CFP — 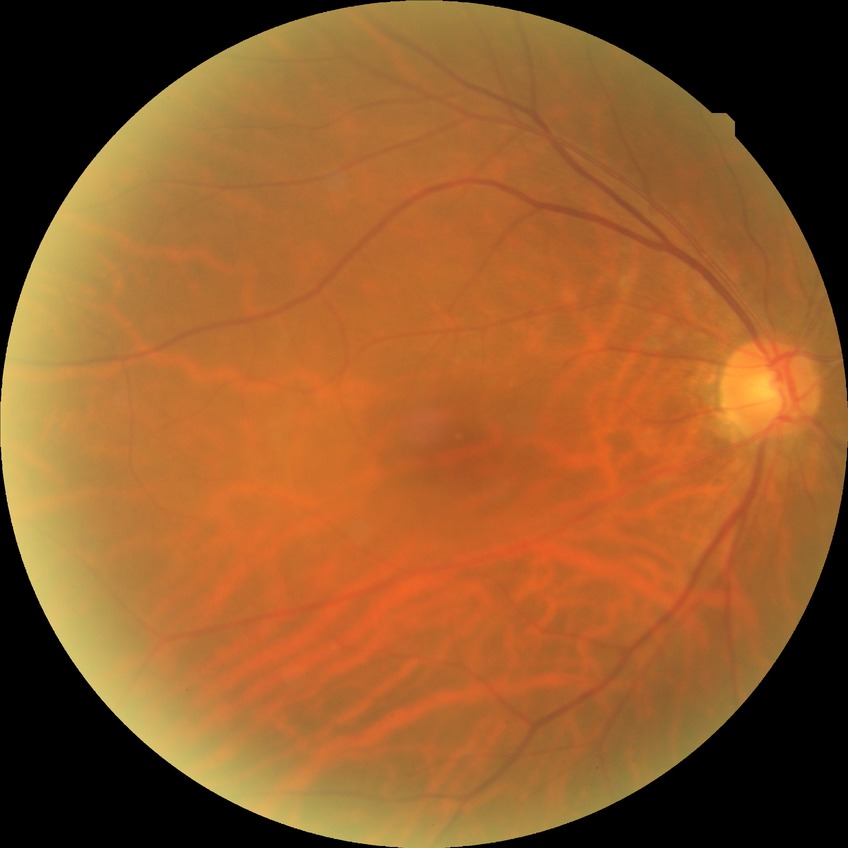

Diabetic retinopathy (DR): NDR (no diabetic retinopathy).